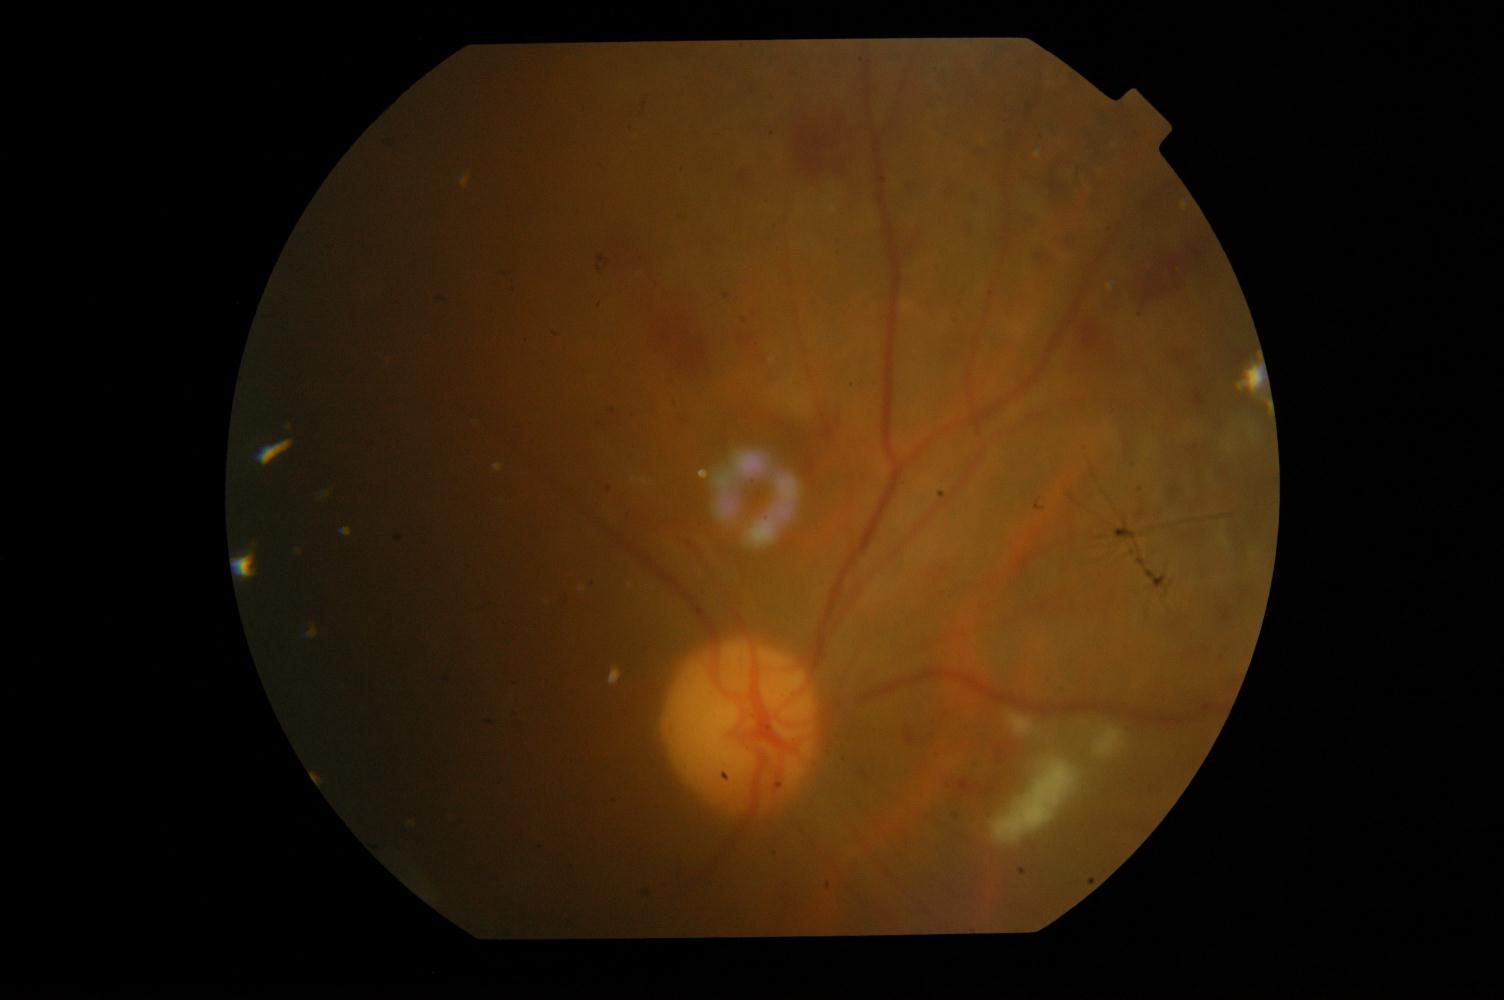

Fundus image with findings of diabetic retinopathy.